Wide-field fundus photograph from neonatal ROP screening — 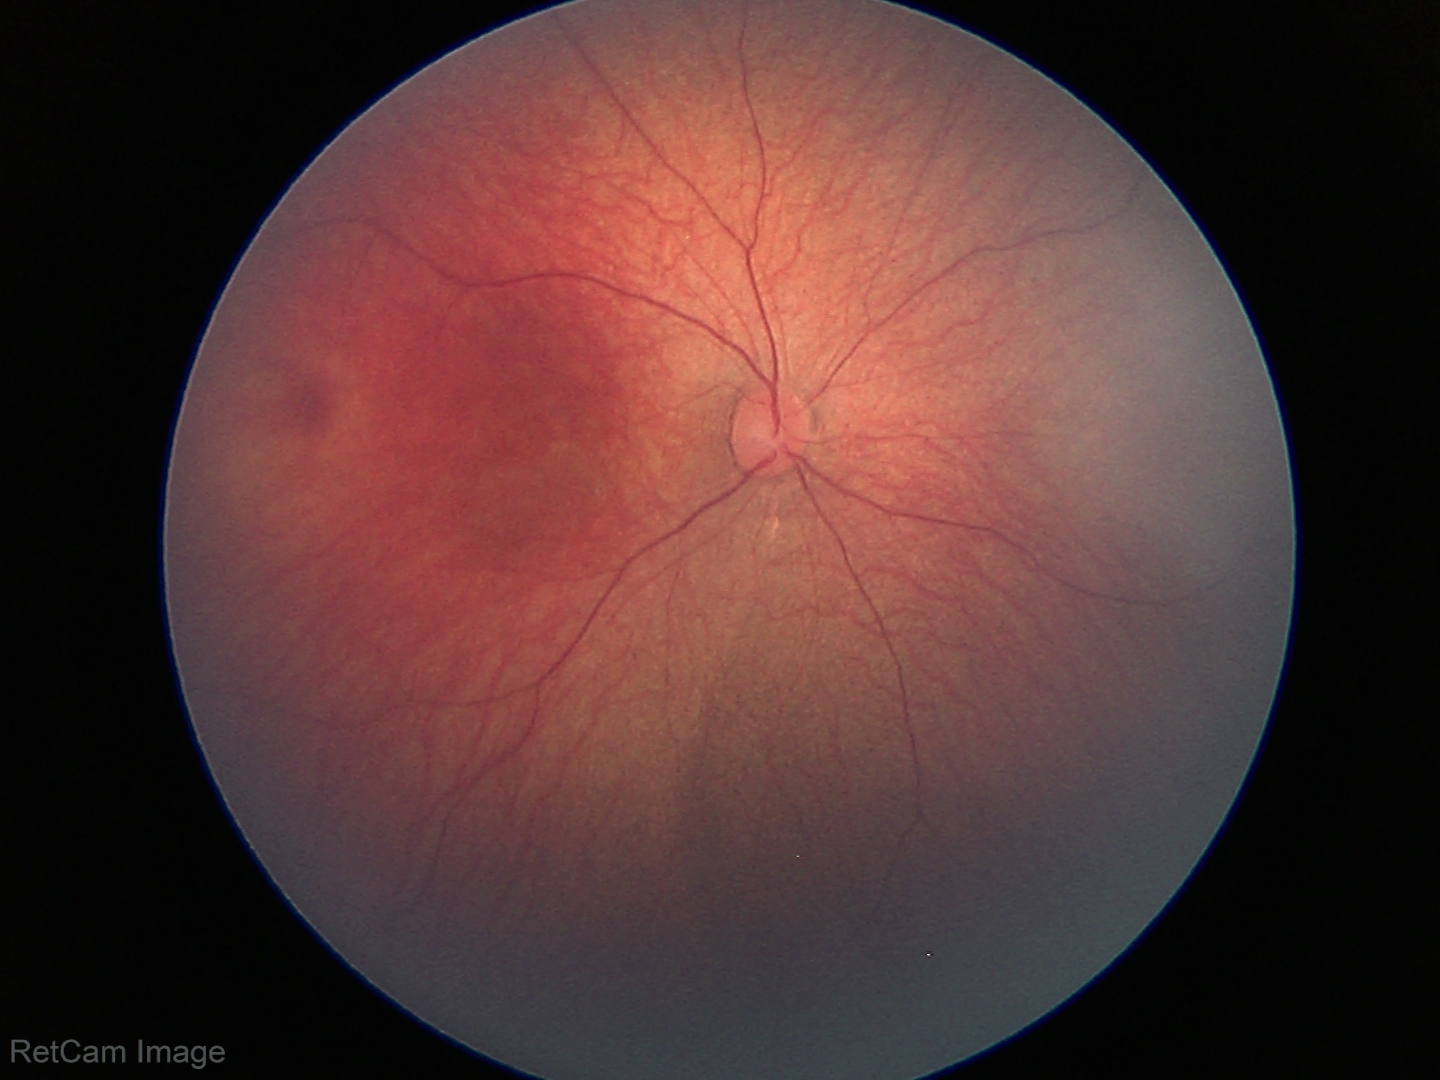
Screening examination with no abnormal retinal findings.